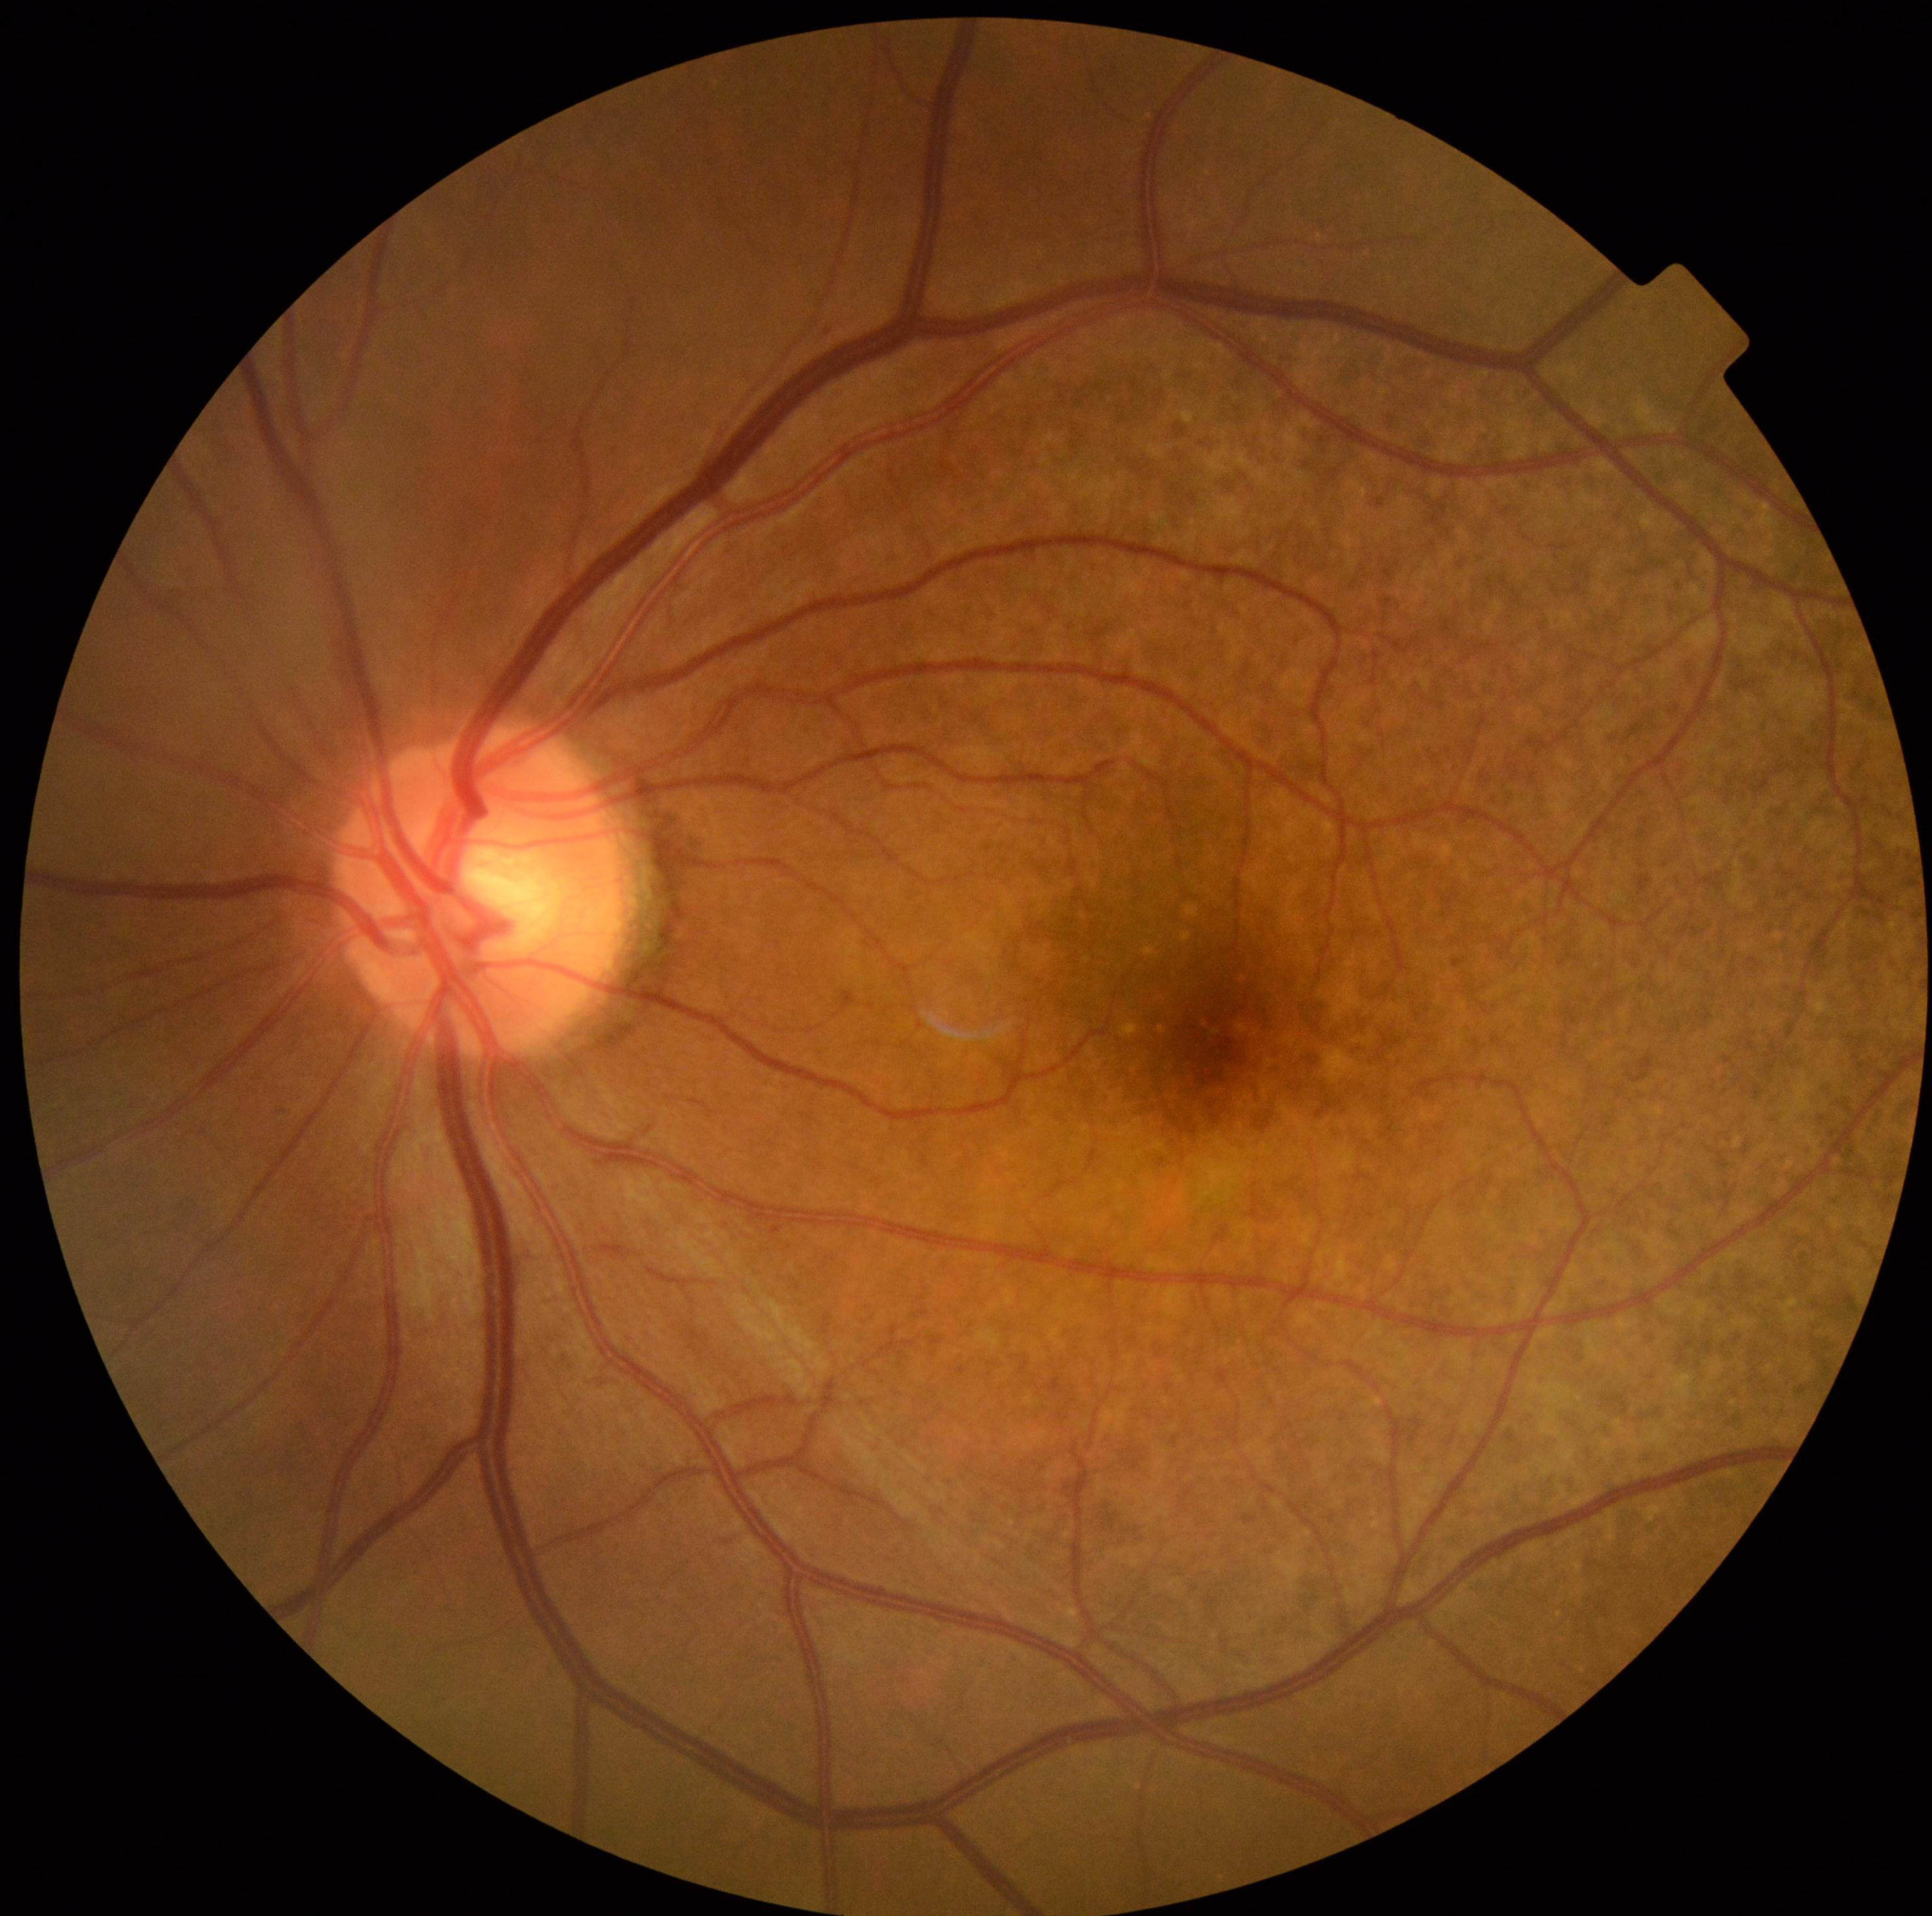
Diabetic retinopathy (DR): grade 1 — presence of microaneurysms only.